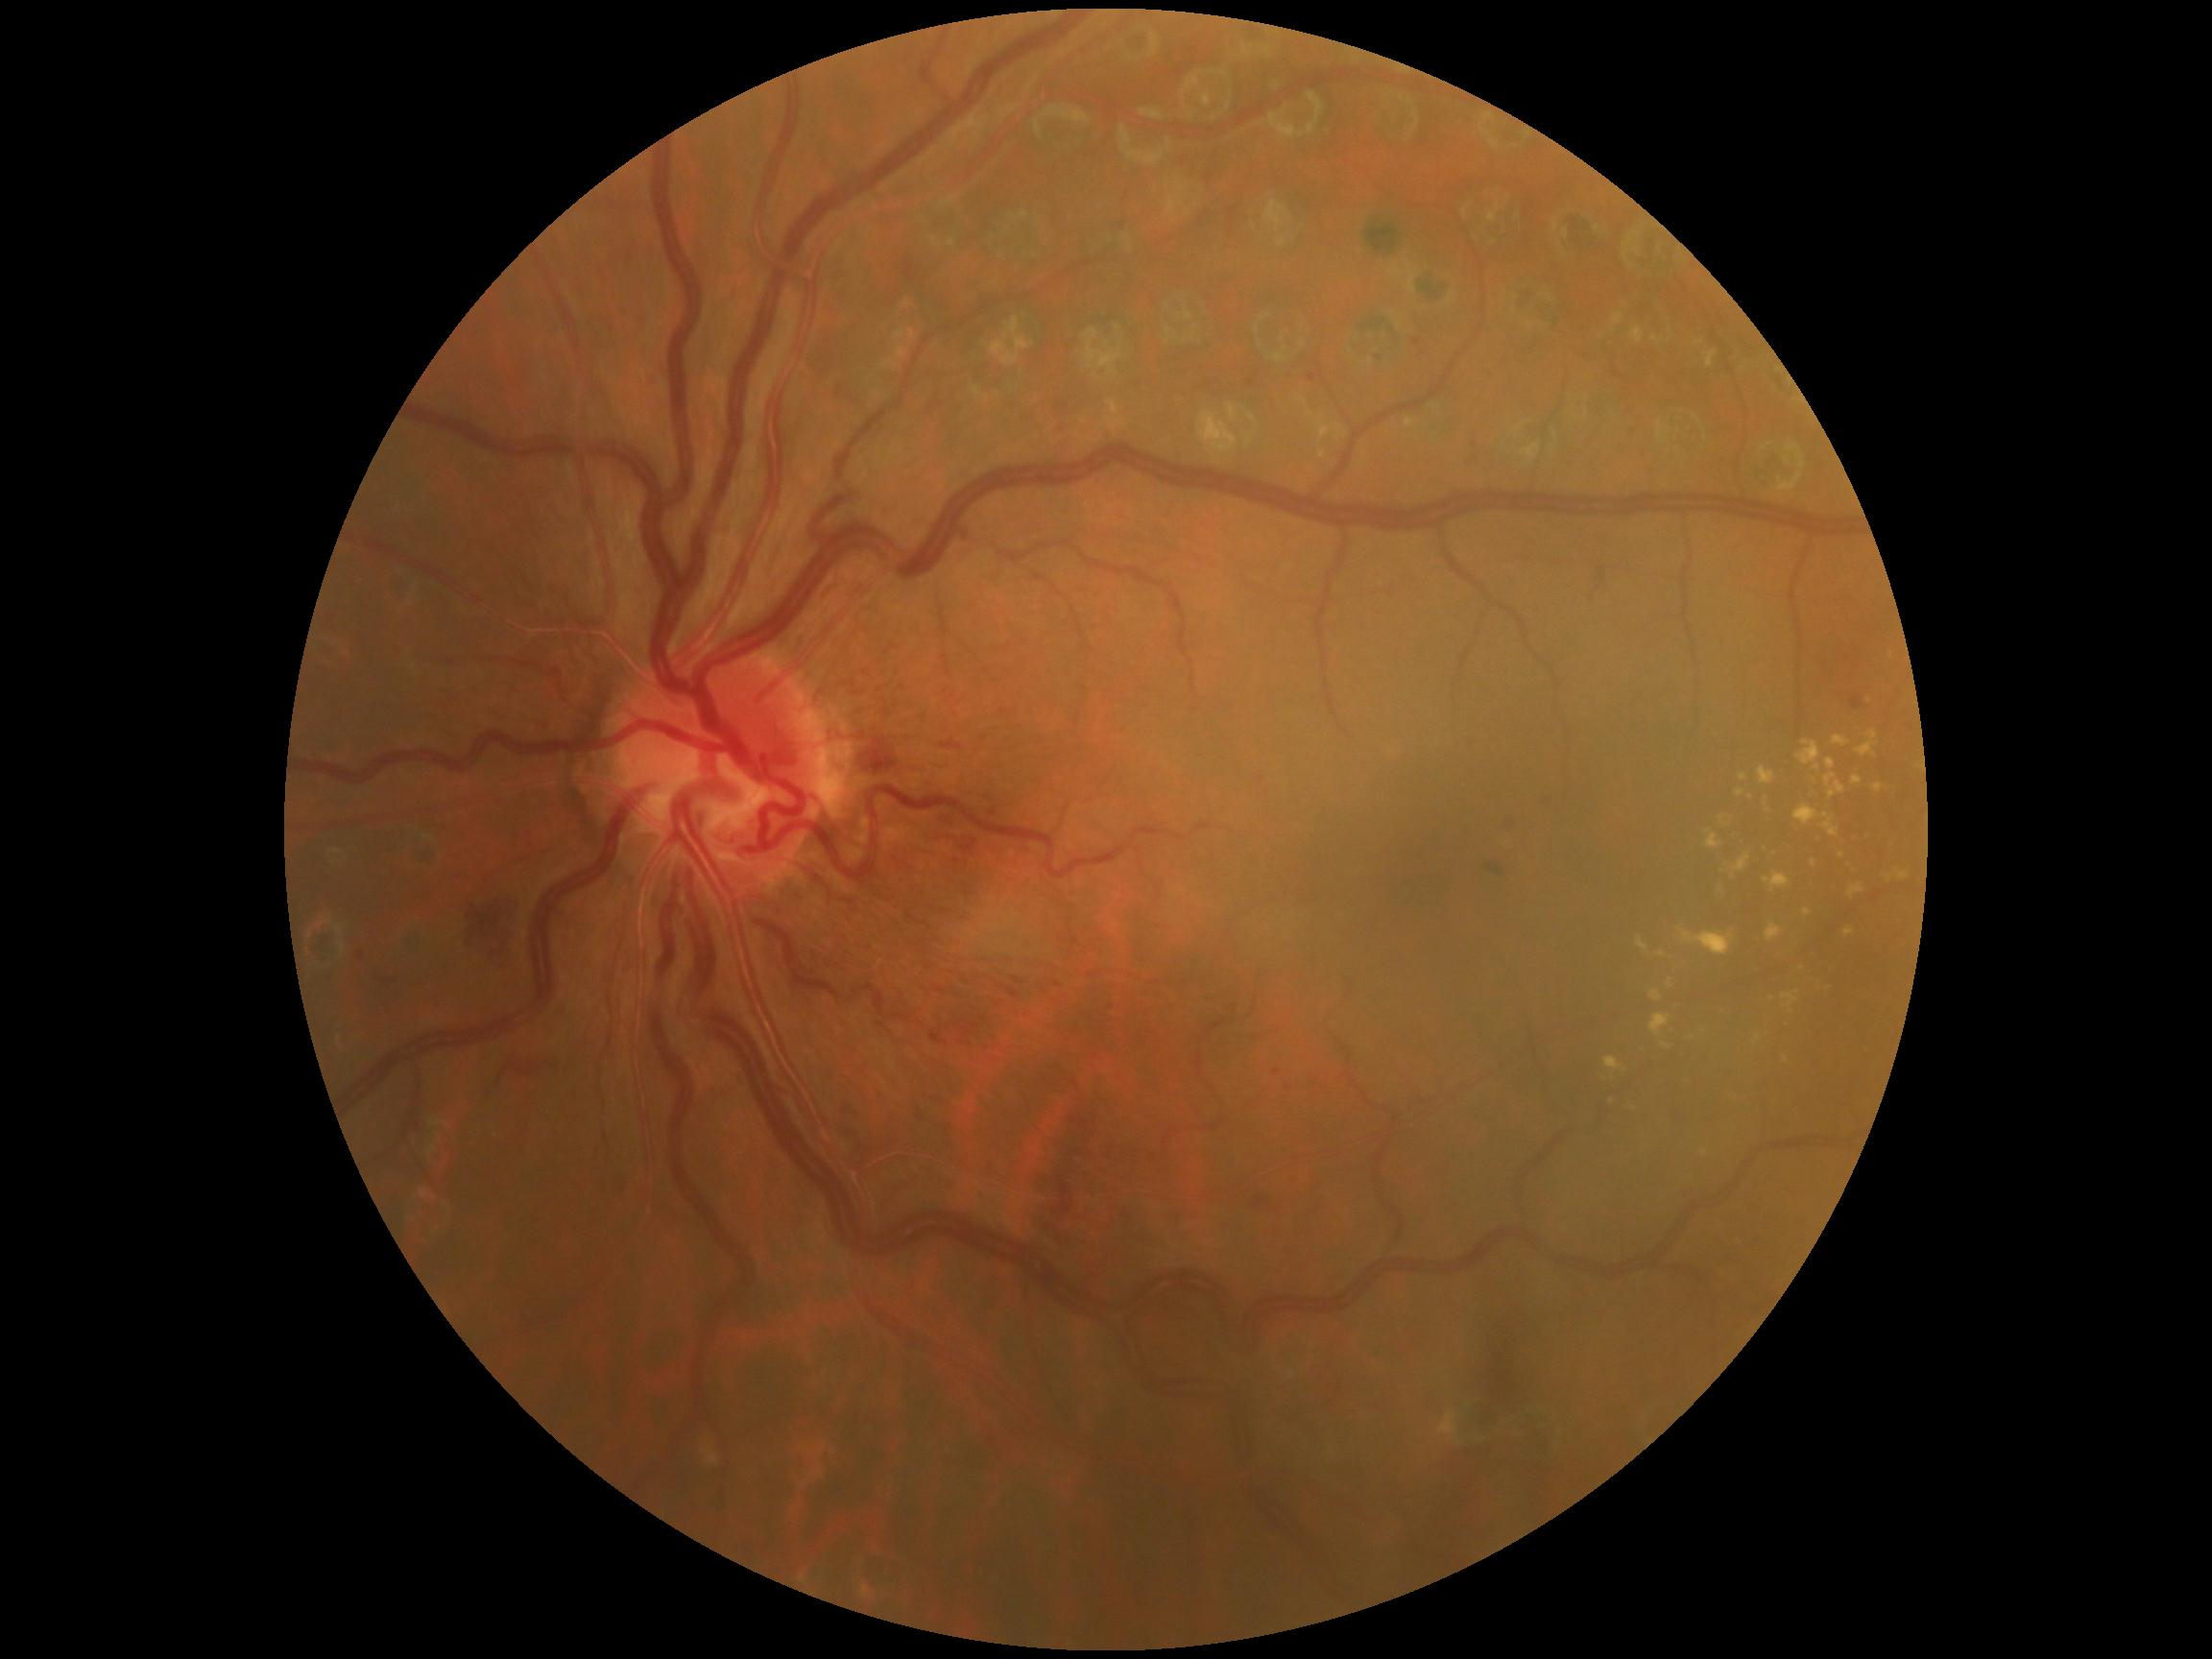

Diabetic retinopathy (DR) is moderate non-proliferative diabetic retinopathy (grade 2) — more than just microaneurysms but less than severe NPDR
Representative lesions:
hard exudates (EXs) (partial): <bbox>1872, 784, 1885, 796</bbox>; <bbox>1825, 773, 1846, 801</bbox>; <bbox>1796, 741, 1820, 773</bbox>; <bbox>1851, 777, 1863, 786</bbox>; <bbox>1705, 830, 1726, 851</bbox>; <bbox>1718, 885, 1725, 895</bbox>; <bbox>1825, 758, 1837, 770</bbox>; <bbox>1832, 736, 1851, 748</bbox>; <bbox>1794, 805, 1820, 827</bbox>; <bbox>1811, 860, 1817, 868</bbox>; <bbox>1766, 923, 1782, 944</bbox>; <bbox>1657, 951, 1668, 959</bbox>
Small EXs approximately at 1869, 701; 1751, 798; 1802, 970; 1692, 1039; 1767, 804; 1672, 1031
hemorrhages (HEs) (partial): <bbox>1059, 405, 1069, 413</bbox>; <bbox>1366, 603, 1393, 627</bbox>; <bbox>1851, 696, 1863, 710</bbox>; <bbox>493, 1052, 566, 1087</bbox>; <bbox>1254, 1200, 1268, 1210</bbox>; <bbox>371, 977, 404, 990</bbox>; <bbox>533, 717, 552, 736</bbox>; <bbox>836, 1128, 862, 1141</bbox>; <bbox>1283, 370, 1297, 384</bbox>; <bbox>1837, 643, 1867, 677</bbox>; <bbox>1457, 732, 1491, 756</bbox>
Small HEs approximately at 1258, 375; 1417, 343; 1277, 1072